Infant wide-field fundus photograph — 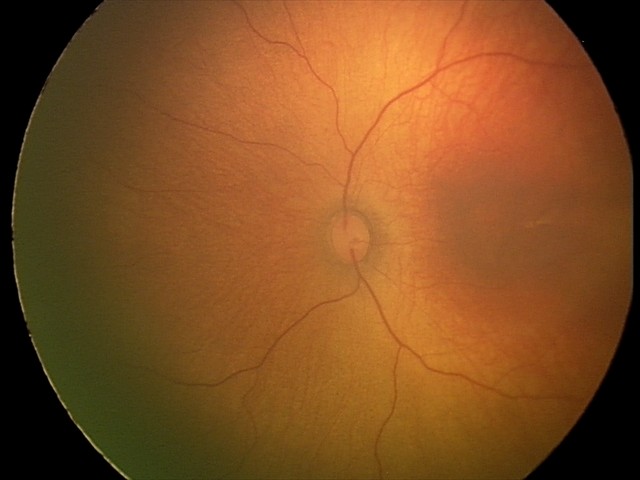 Impression: physiological appearance with no retinal pathology.